Fundus photo: 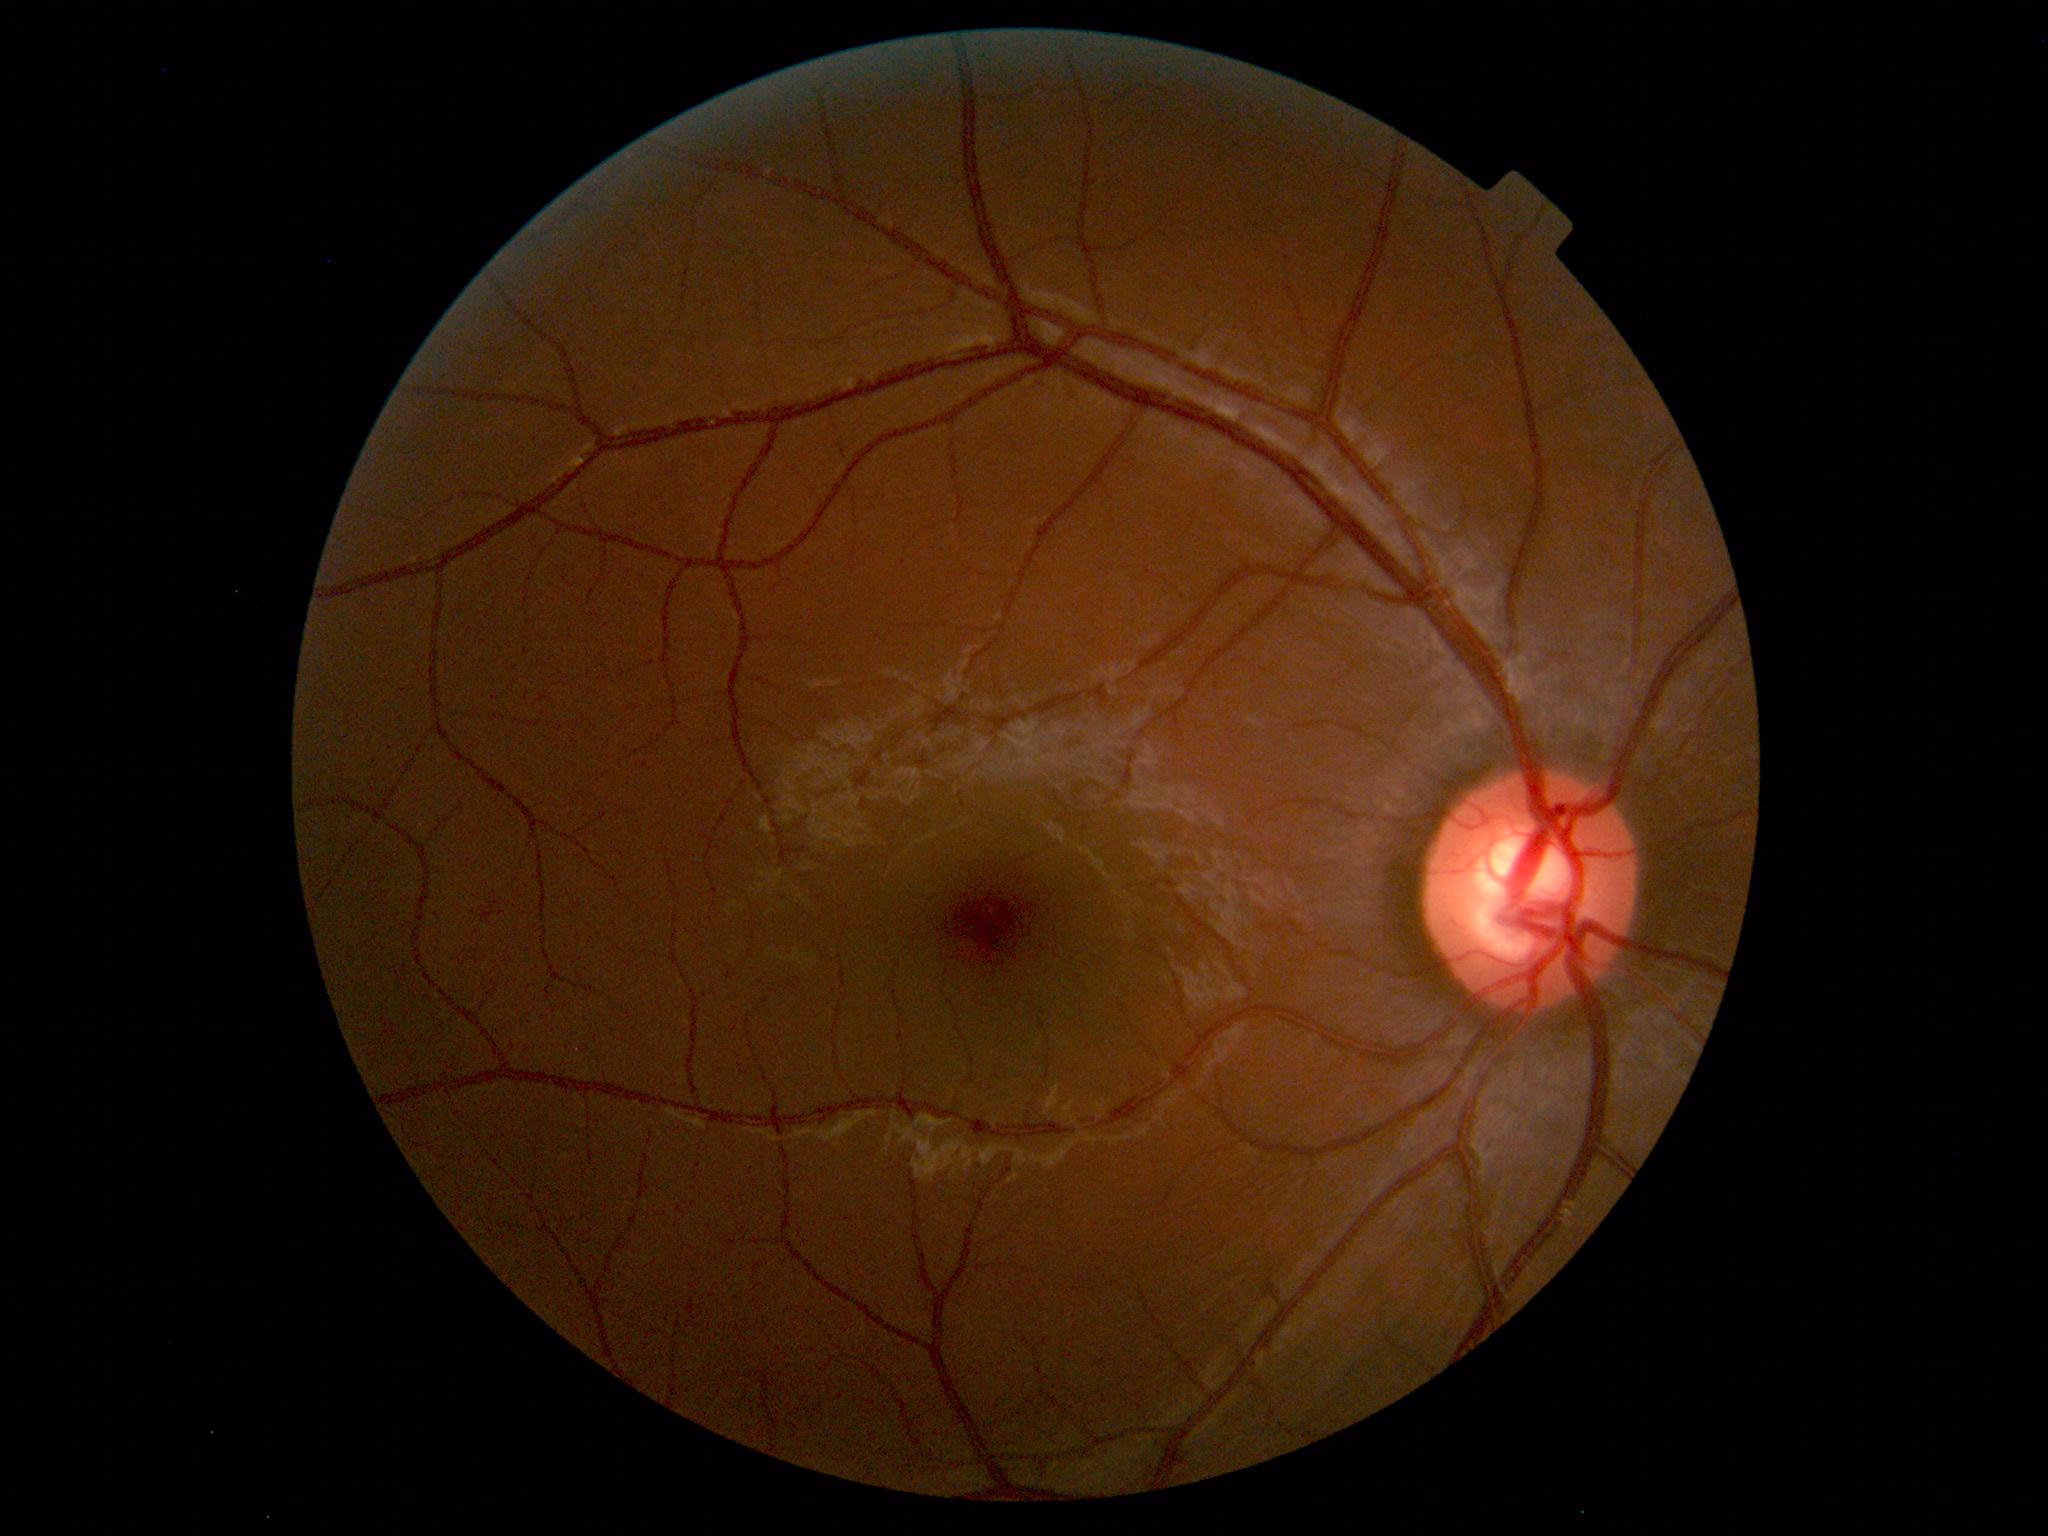 No retinal pathology identified.